2352x1568: 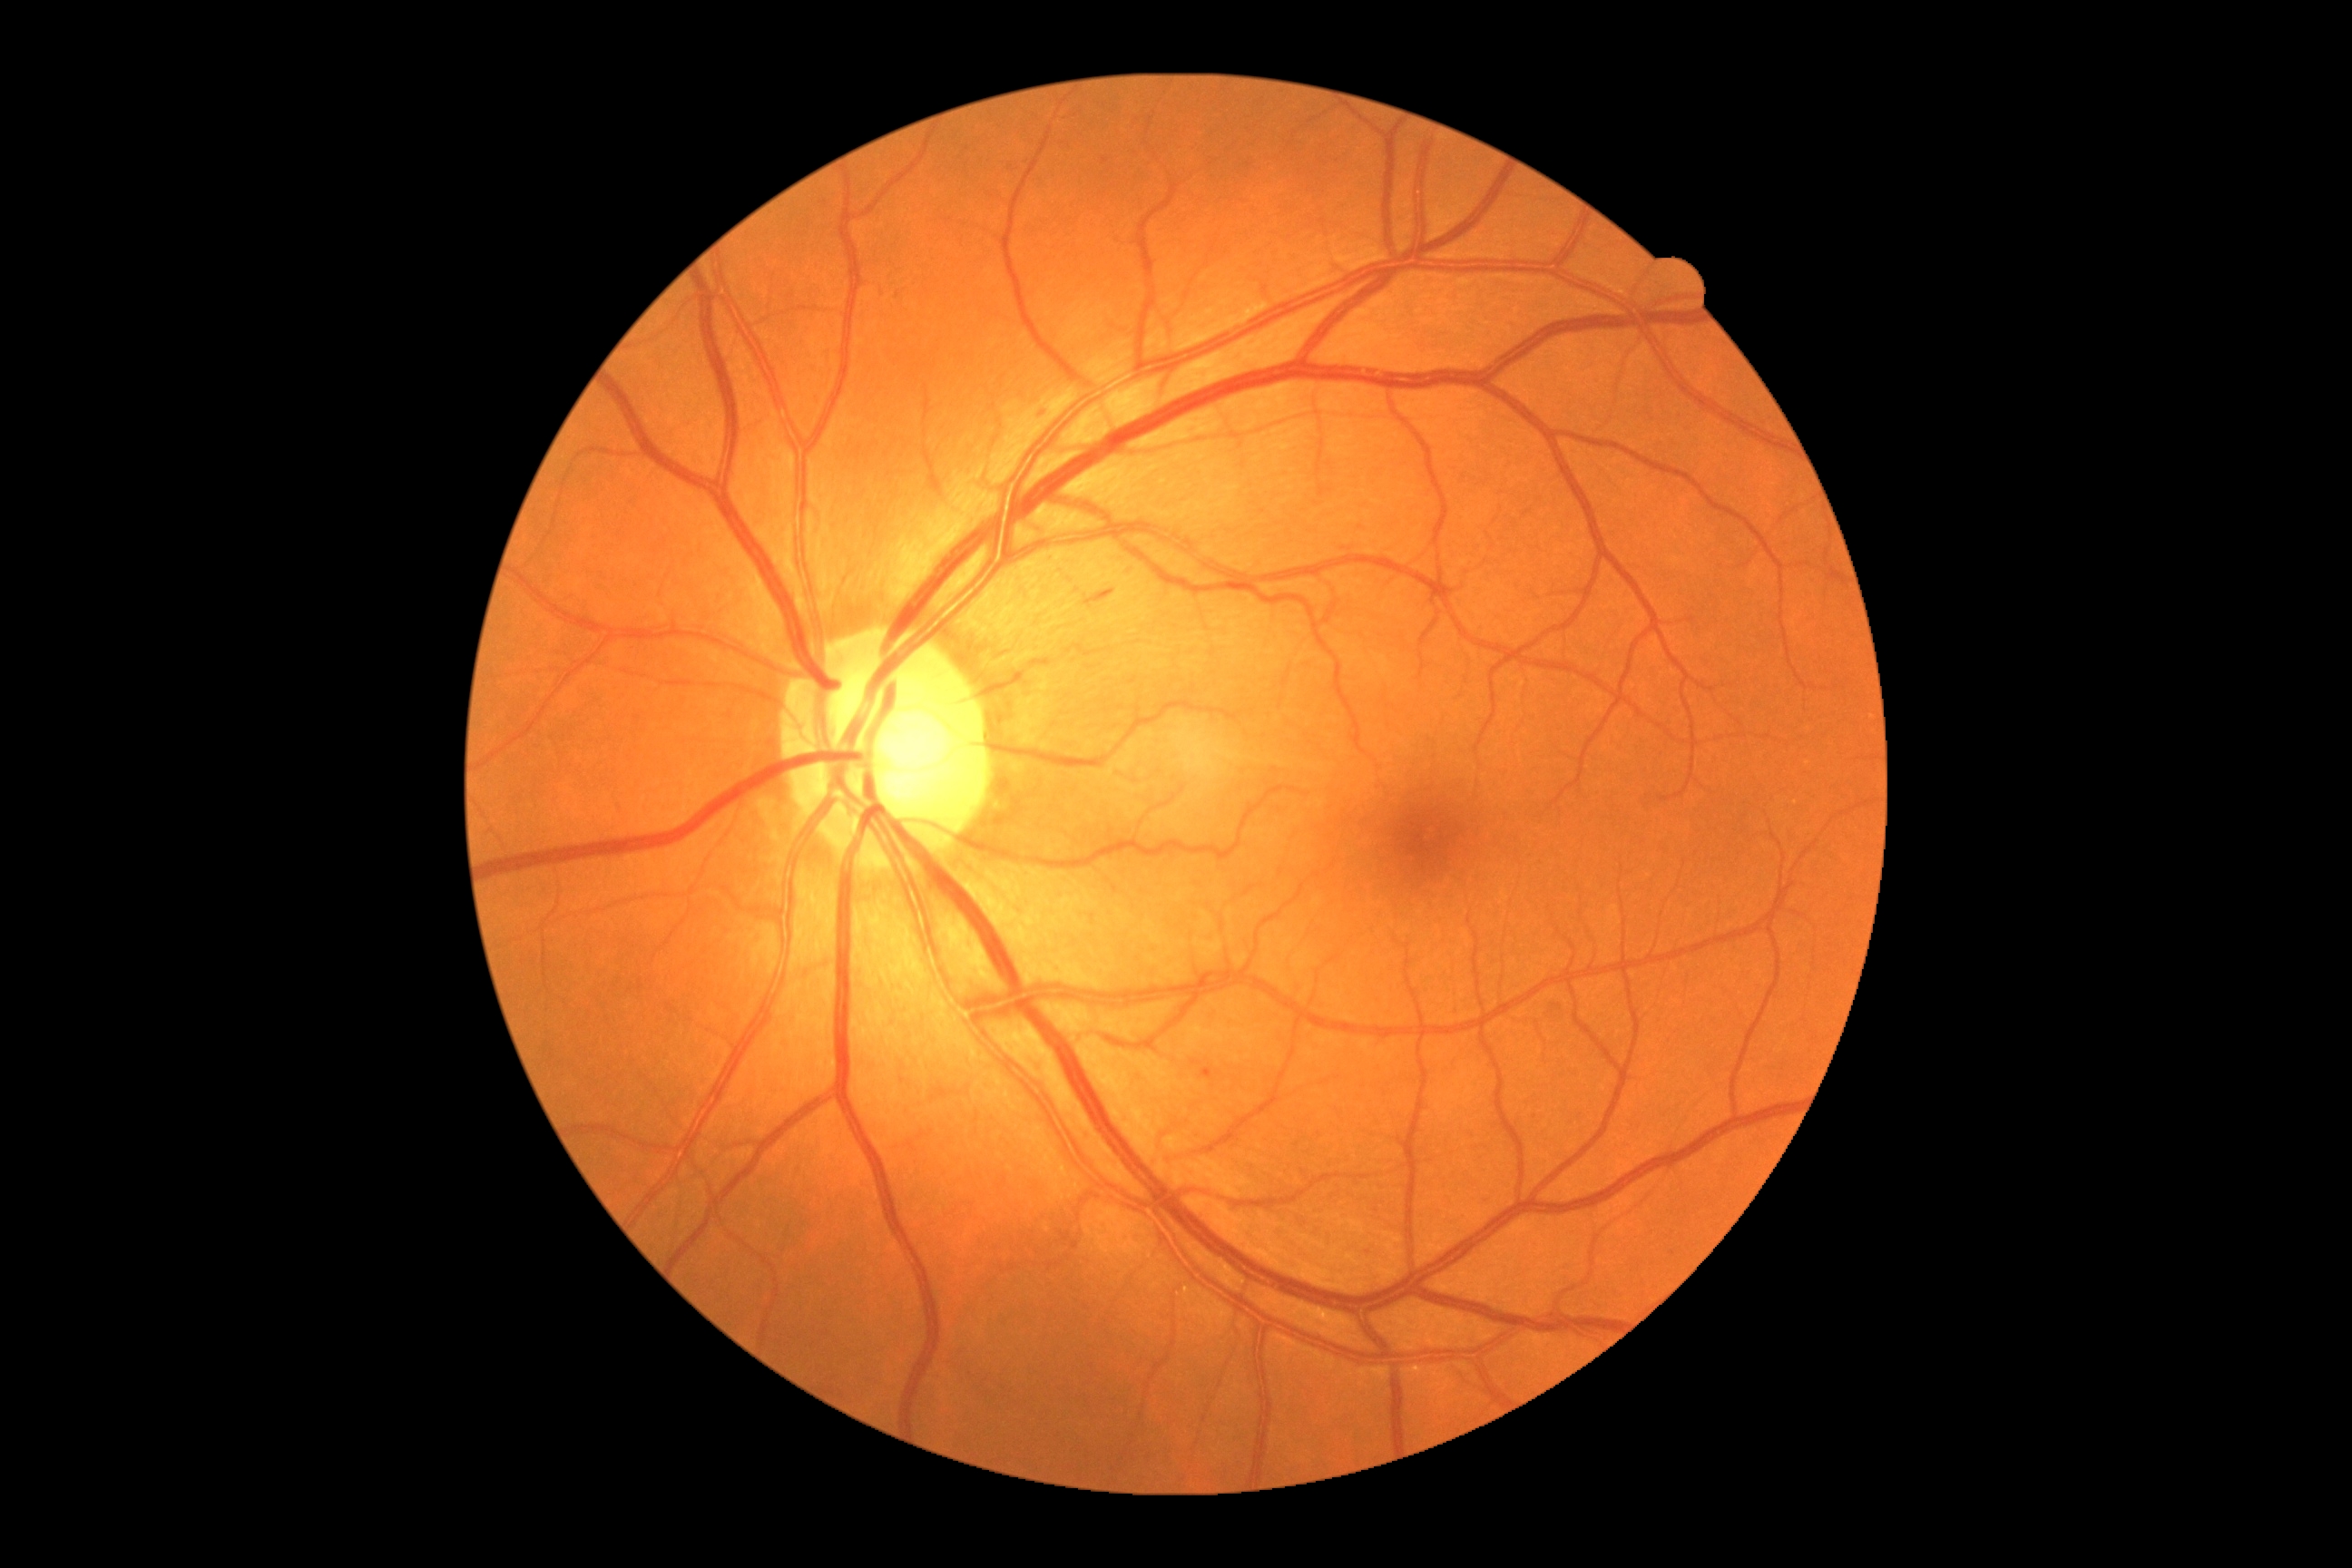

DR: 2.